Wide-field retinal mosaic image
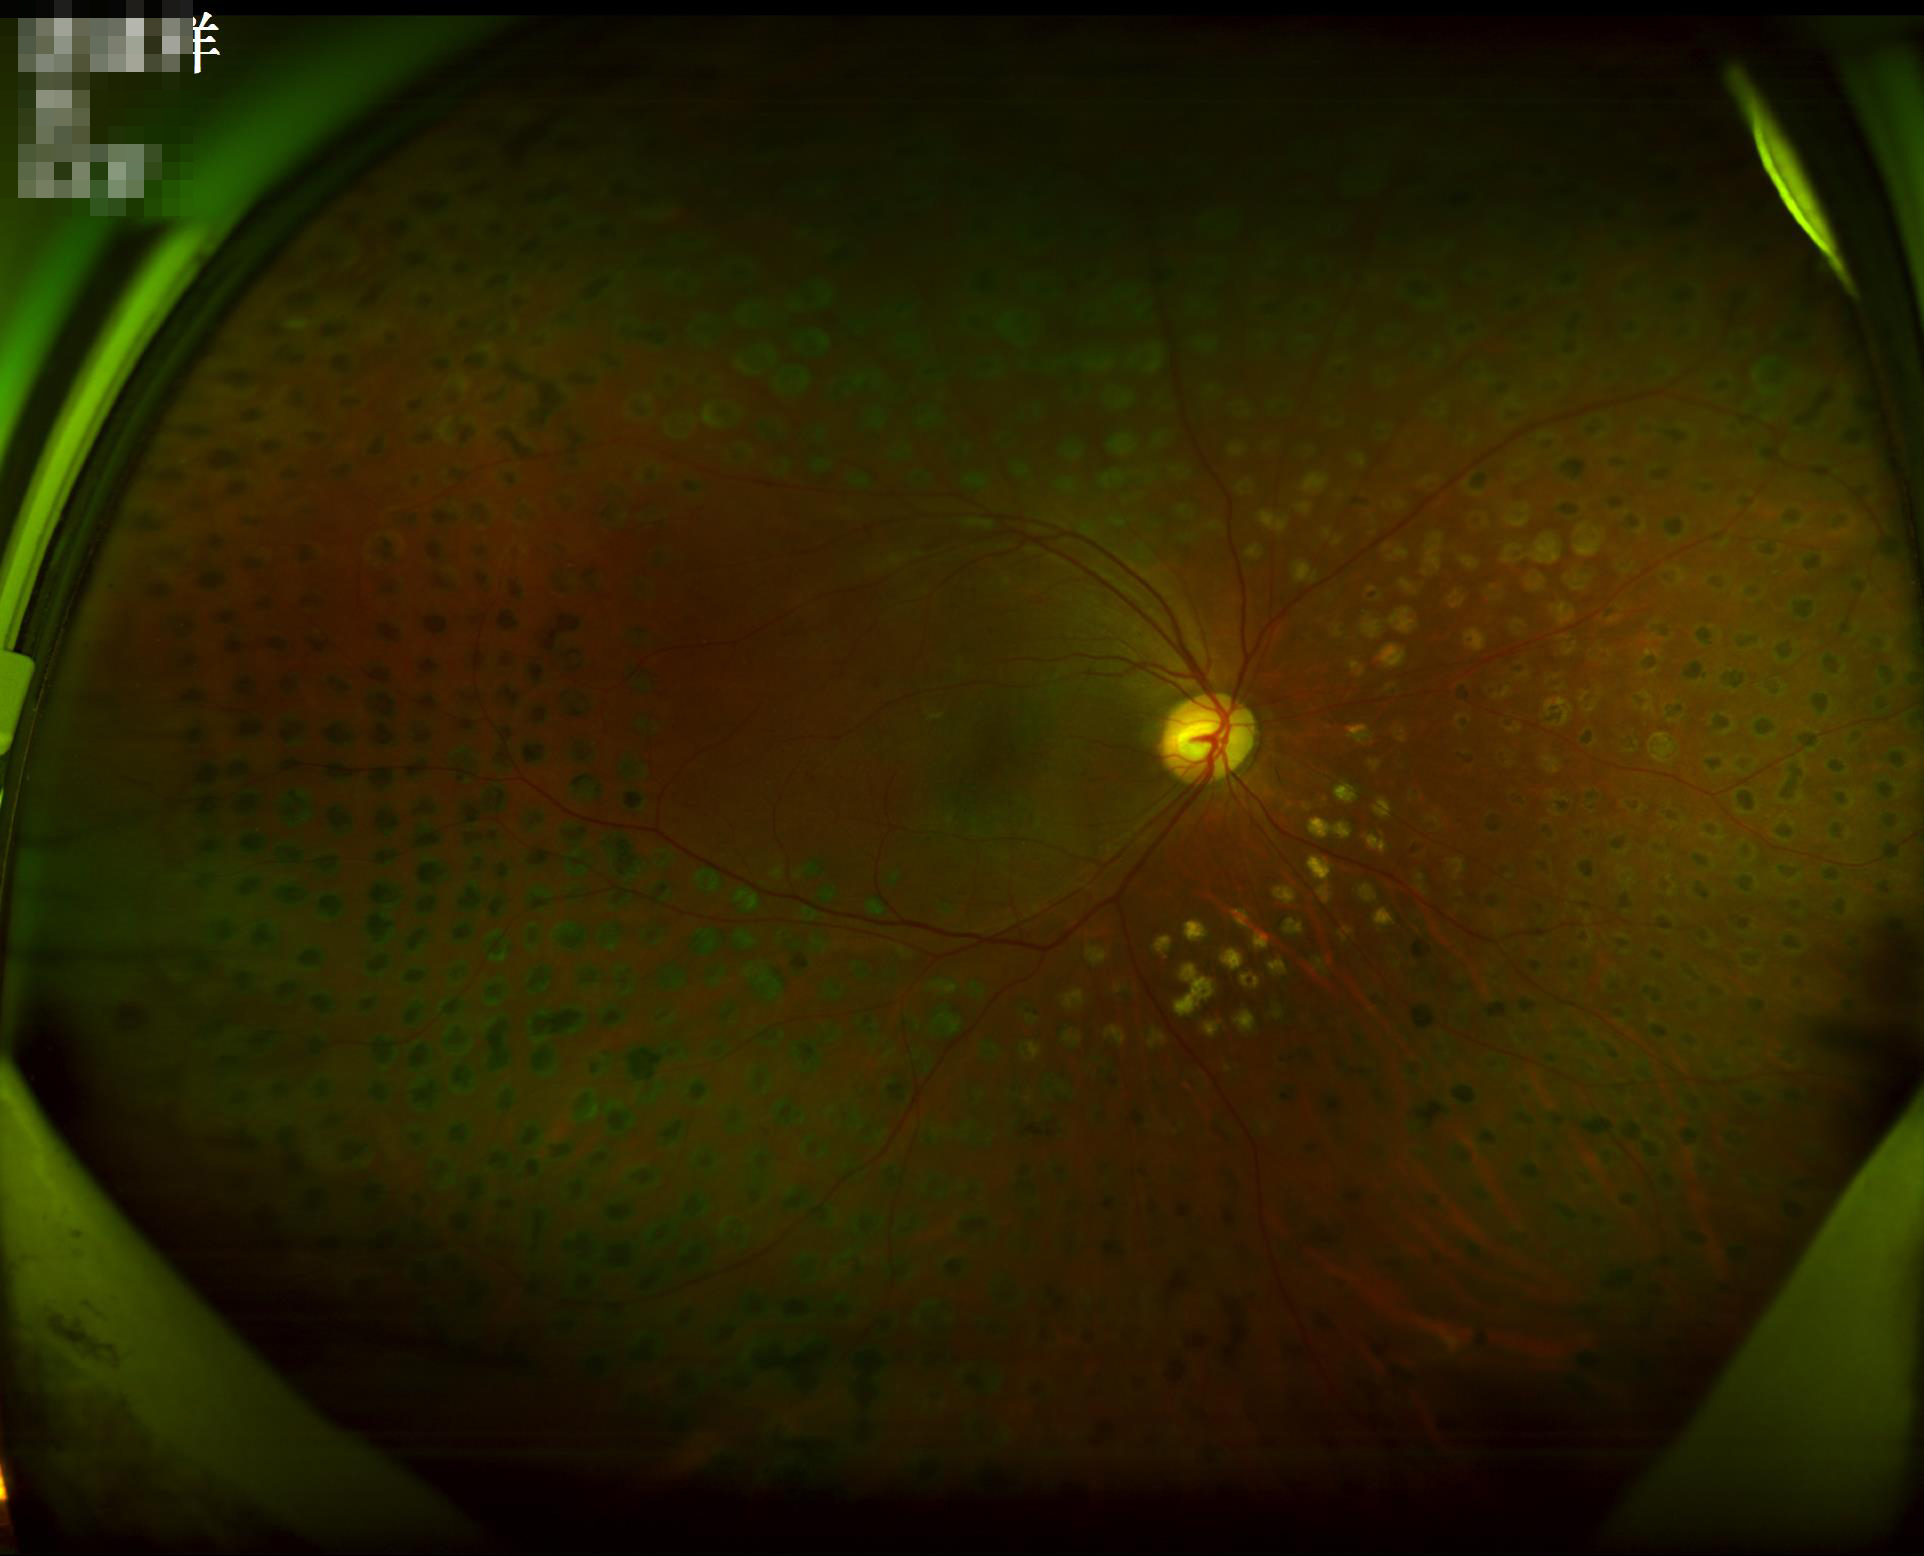
{"contrast": "good dynamic range", "overall_quality": "good and suitable for diagnostic use", "illumination": "inadequate, with uneven exposure or color distortion", "clarity": "optic disc, vessels, and background in focus"}